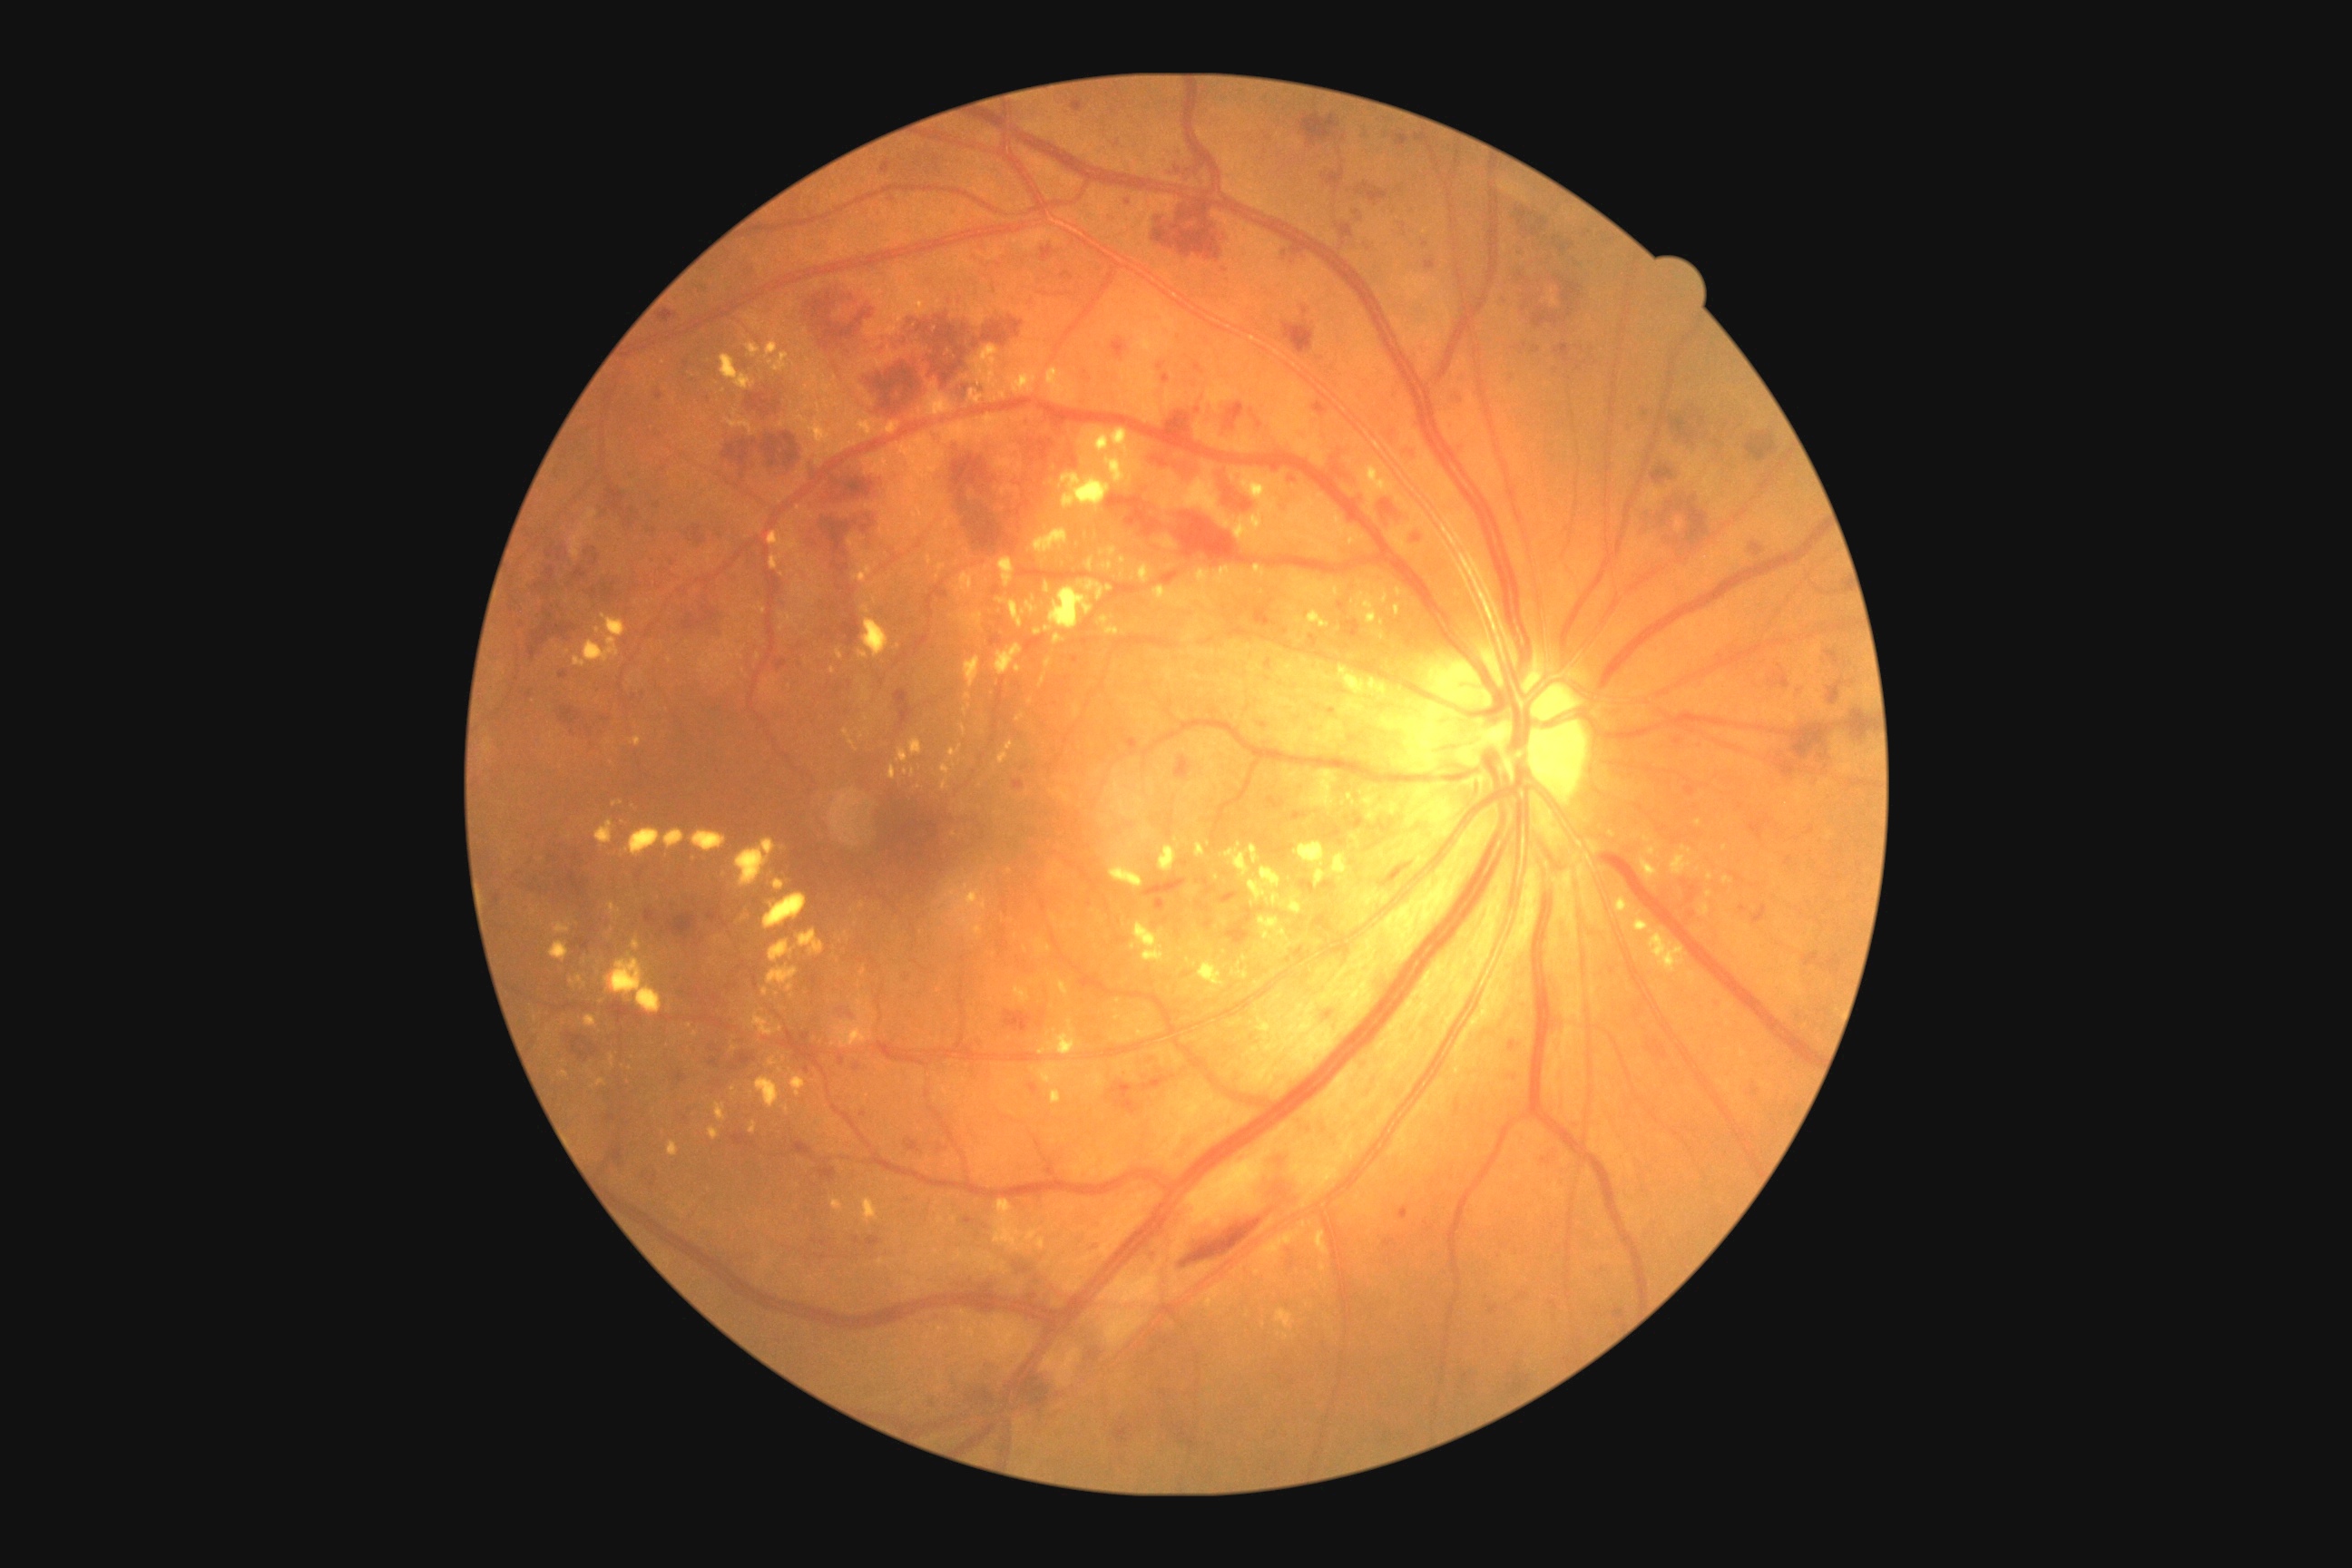
Diabetic retinopathy (DR) is grade 3.
Hemorrhages (HEs) include those at {"x1": 1453, "y1": 395, "x2": 1464, "y2": 402}; {"x1": 567, "y1": 1032, "x2": 600, "y2": 1063}; {"x1": 979, "y1": 485, "x2": 988, "y2": 496}; {"x1": 823, "y1": 632, "x2": 834, "y2": 643}; {"x1": 1776, "y1": 752, "x2": 1798, "y2": 778}; {"x1": 1298, "y1": 113, "x2": 1342, "y2": 150}; {"x1": 658, "y1": 309, "x2": 678, "y2": 324}; {"x1": 1533, "y1": 277, "x2": 1583, "y2": 329}; {"x1": 1509, "y1": 1375, "x2": 1531, "y2": 1396}; {"x1": 1019, "y1": 1291, "x2": 1037, "y2": 1304}; {"x1": 729, "y1": 1132, "x2": 756, "y2": 1146}; {"x1": 1658, "y1": 397, "x2": 1698, "y2": 447}; {"x1": 1752, "y1": 905, "x2": 1769, "y2": 926}; {"x1": 729, "y1": 1052, "x2": 756, "y2": 1073}; {"x1": 667, "y1": 914, "x2": 698, "y2": 941}; {"x1": 1173, "y1": 513, "x2": 1257, "y2": 567}; {"x1": 1222, "y1": 475, "x2": 1253, "y2": 513}.
Small HEs near (x=1011, y=512); (x=622, y=677); (x=1226, y=271).
Hard exudates (EXs) include those at {"x1": 1338, "y1": 669, "x2": 1409, "y2": 718}; {"x1": 1113, "y1": 779, "x2": 1122, "y2": 790}; {"x1": 756, "y1": 1077, "x2": 781, "y2": 1110}; {"x1": 629, "y1": 736, "x2": 642, "y2": 747}; {"x1": 792, "y1": 1075, "x2": 807, "y2": 1097}; {"x1": 1054, "y1": 634, "x2": 1064, "y2": 645}; {"x1": 858, "y1": 995, "x2": 863, "y2": 1006}; {"x1": 1355, "y1": 589, "x2": 1389, "y2": 625}; {"x1": 554, "y1": 923, "x2": 571, "y2": 934}; {"x1": 736, "y1": 839, "x2": 776, "y2": 887}; {"x1": 1338, "y1": 865, "x2": 1355, "y2": 879}; {"x1": 1133, "y1": 712, "x2": 1144, "y2": 720}; {"x1": 1121, "y1": 556, "x2": 1126, "y2": 565}; {"x1": 863, "y1": 1199, "x2": 879, "y2": 1224}; {"x1": 769, "y1": 939, "x2": 796, "y2": 963}.
Small EXs near (x=856, y=924); (x=1118, y=773); (x=1133, y=577); (x=689, y=1025).